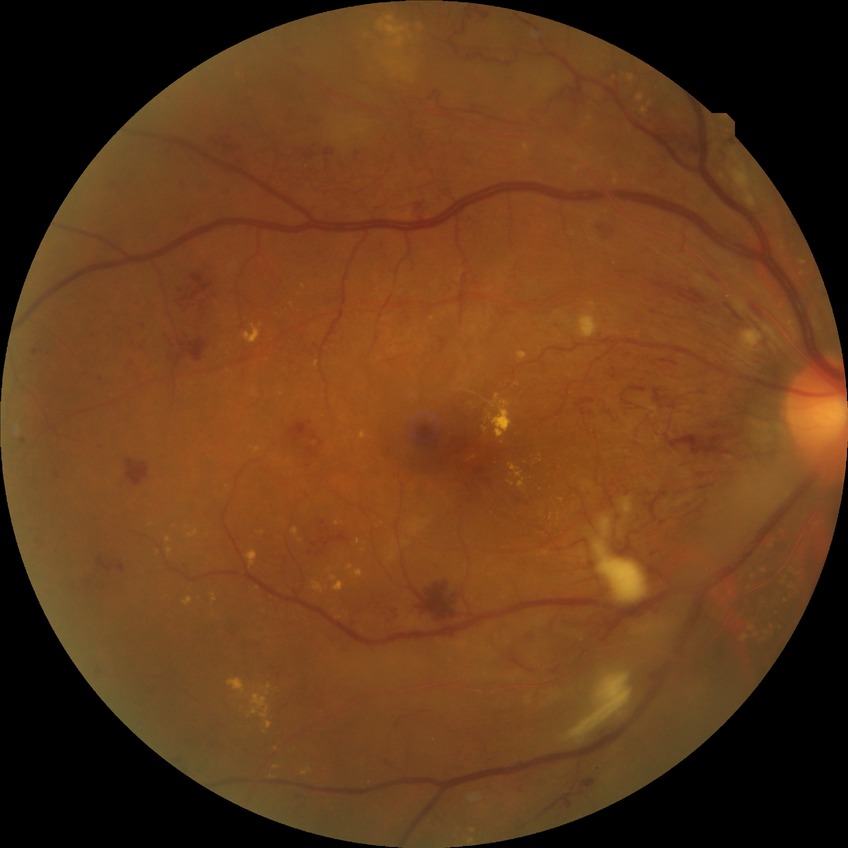

- DR: PDR